Phoenix ICON, 100° FOV; wide-field fundus photograph of an infant.
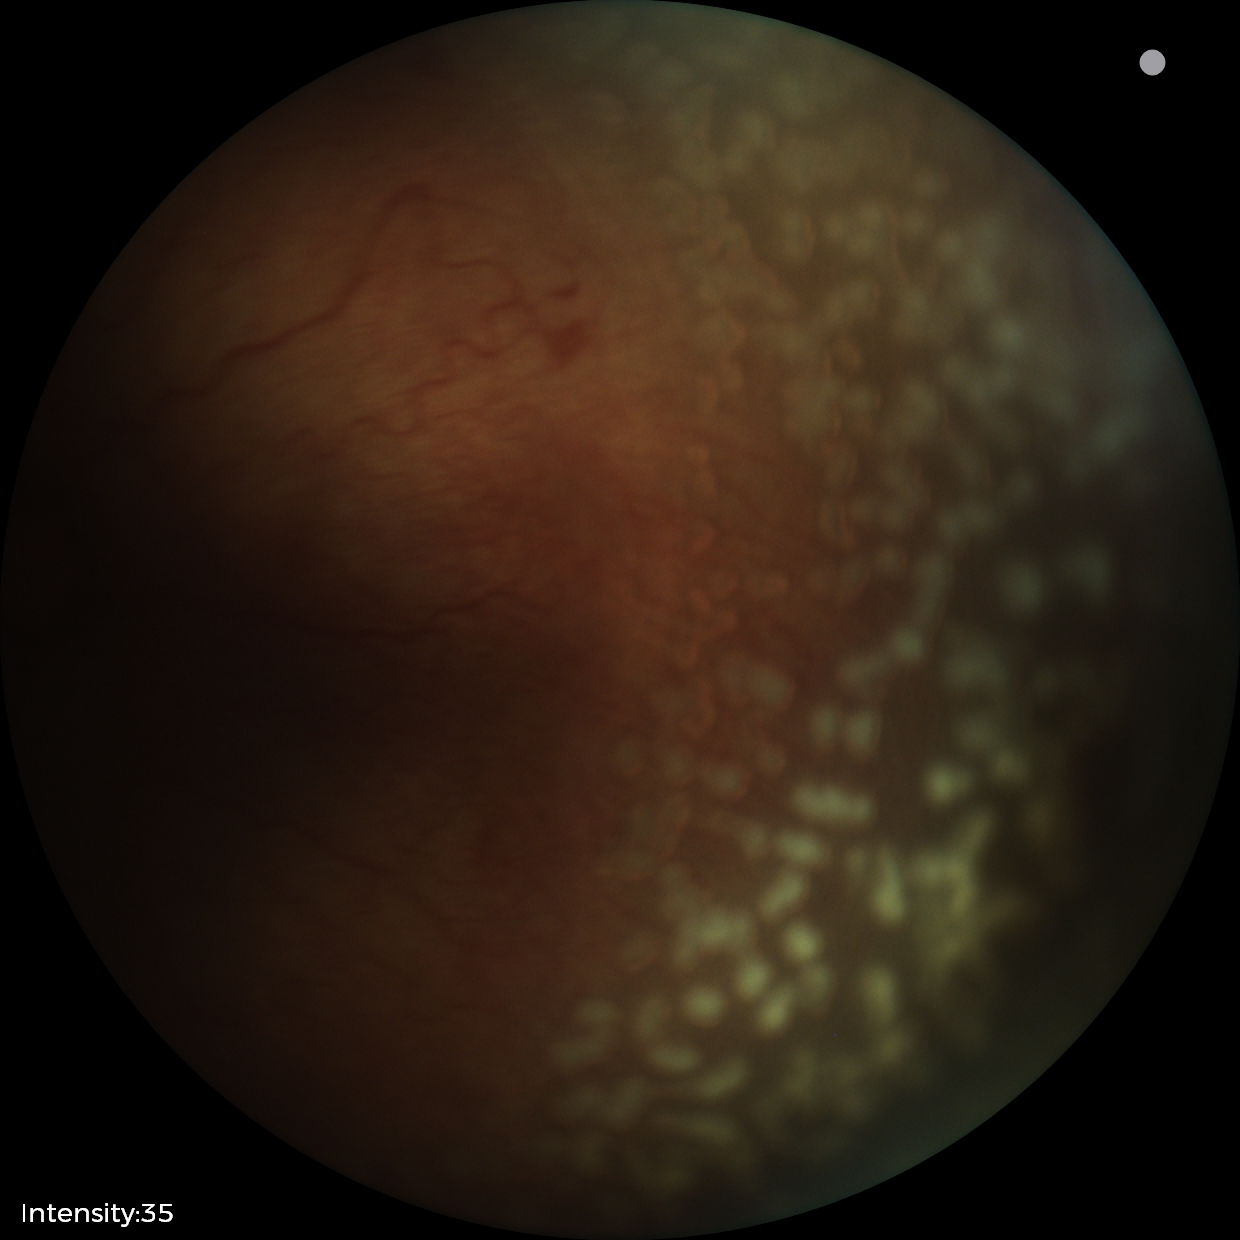

Plus disease: present
impression: retinopathy of prematurity stage 2